Captured without pupil dilation: 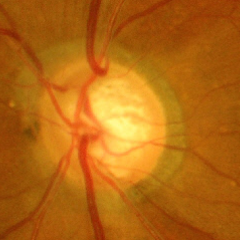
Advanced glaucoma.